No pharmacologic dilation; acquired with a NIDEK AFC-230; 45-degree field of view:
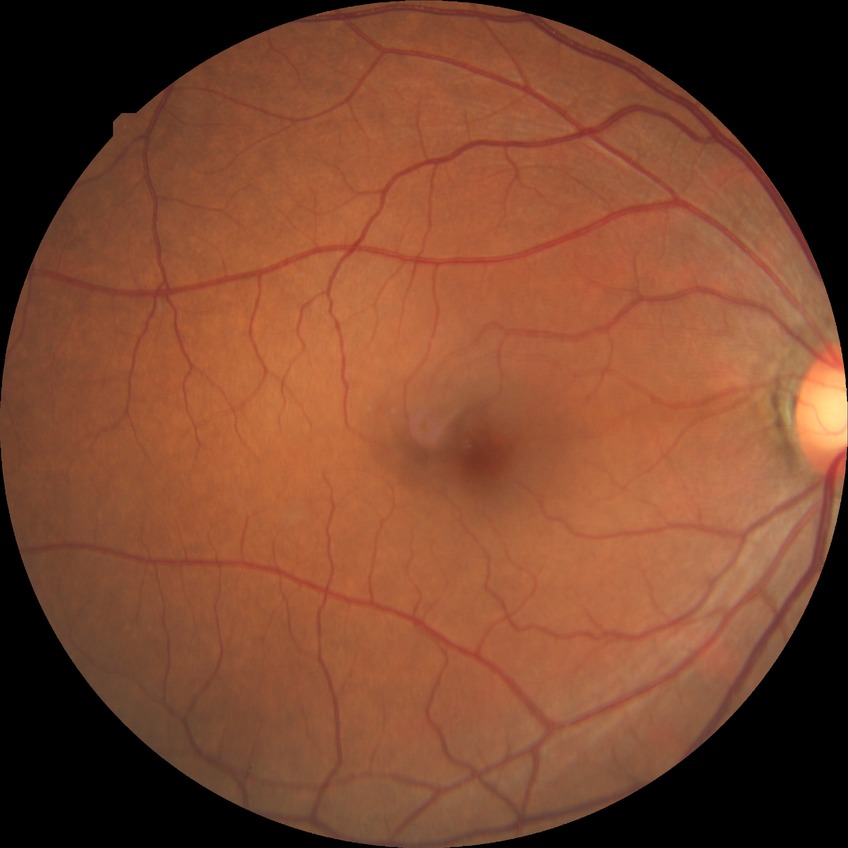

Diabetic retinopathy (DR): NDR (no diabetic retinopathy).